45-degree field of view. 2368 x 1568 pixels. Color fundus image
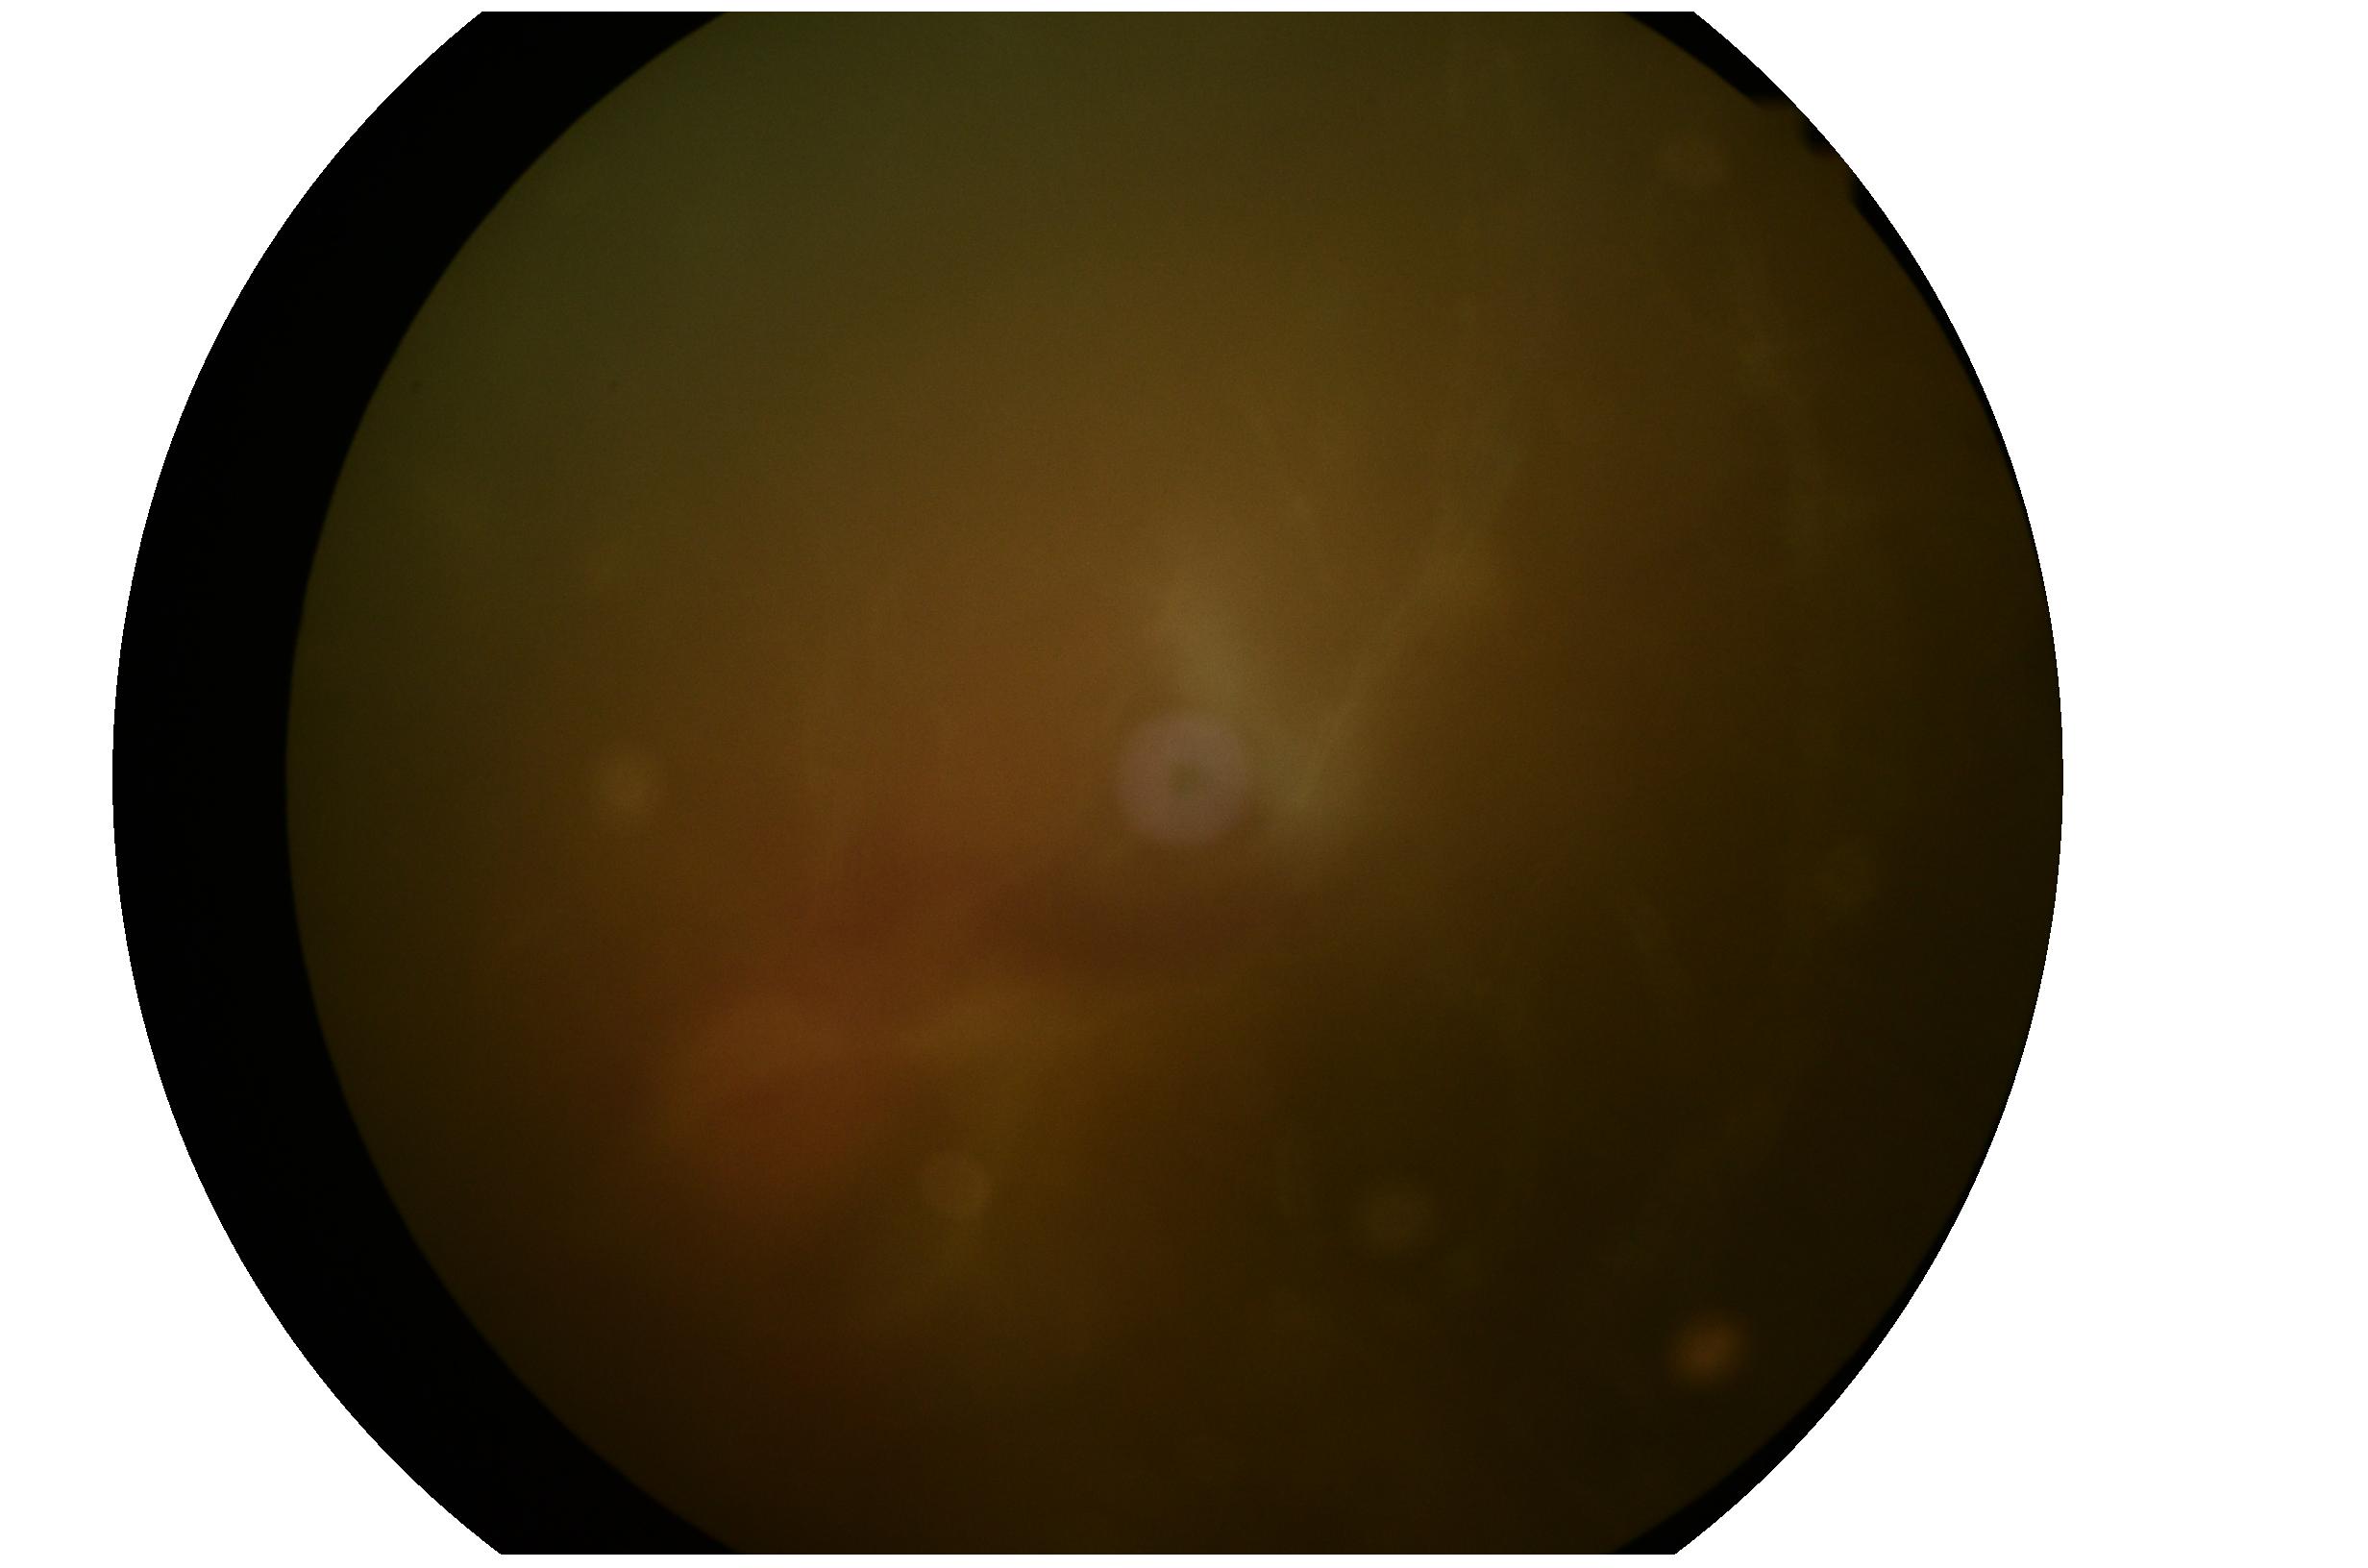
The retinopathy is classified as proliferative diabetic retinopathy.
Diabetic retinopathy (DR) is 4 — neovascularization and/or vitreous/pre-retinal hemorrhage.